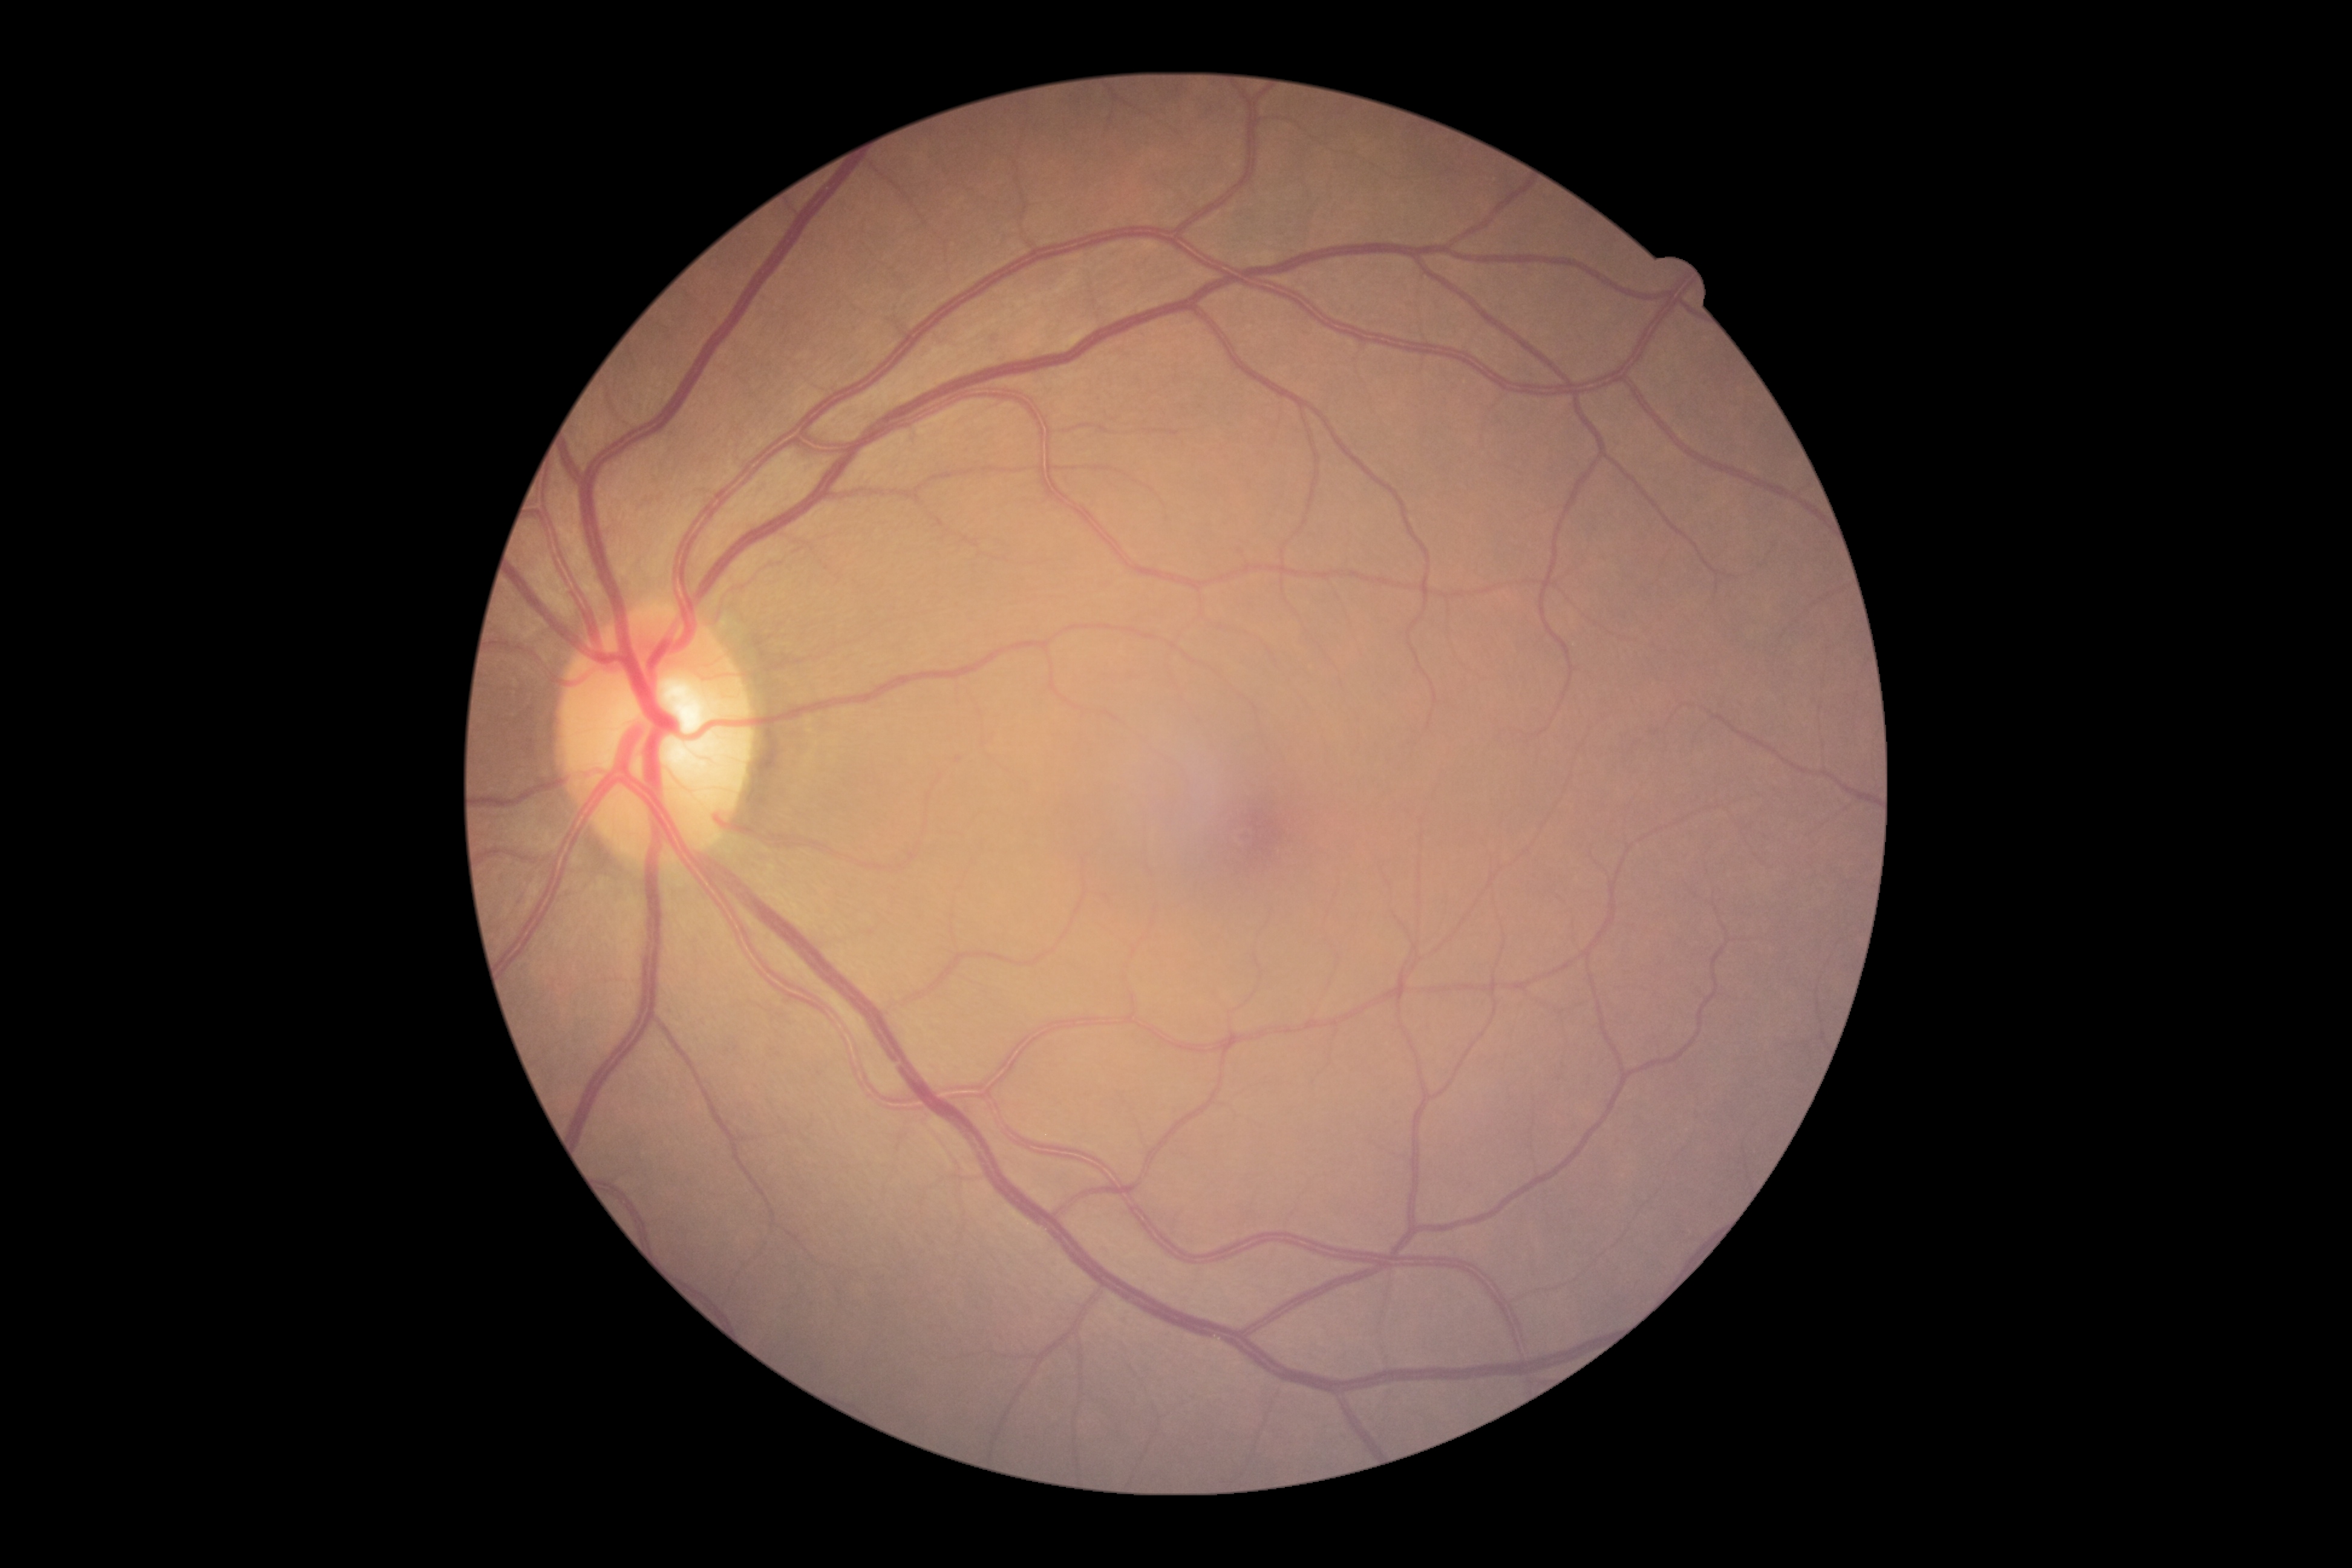 retinopathy grade@0, DR impression@no apparent DR.